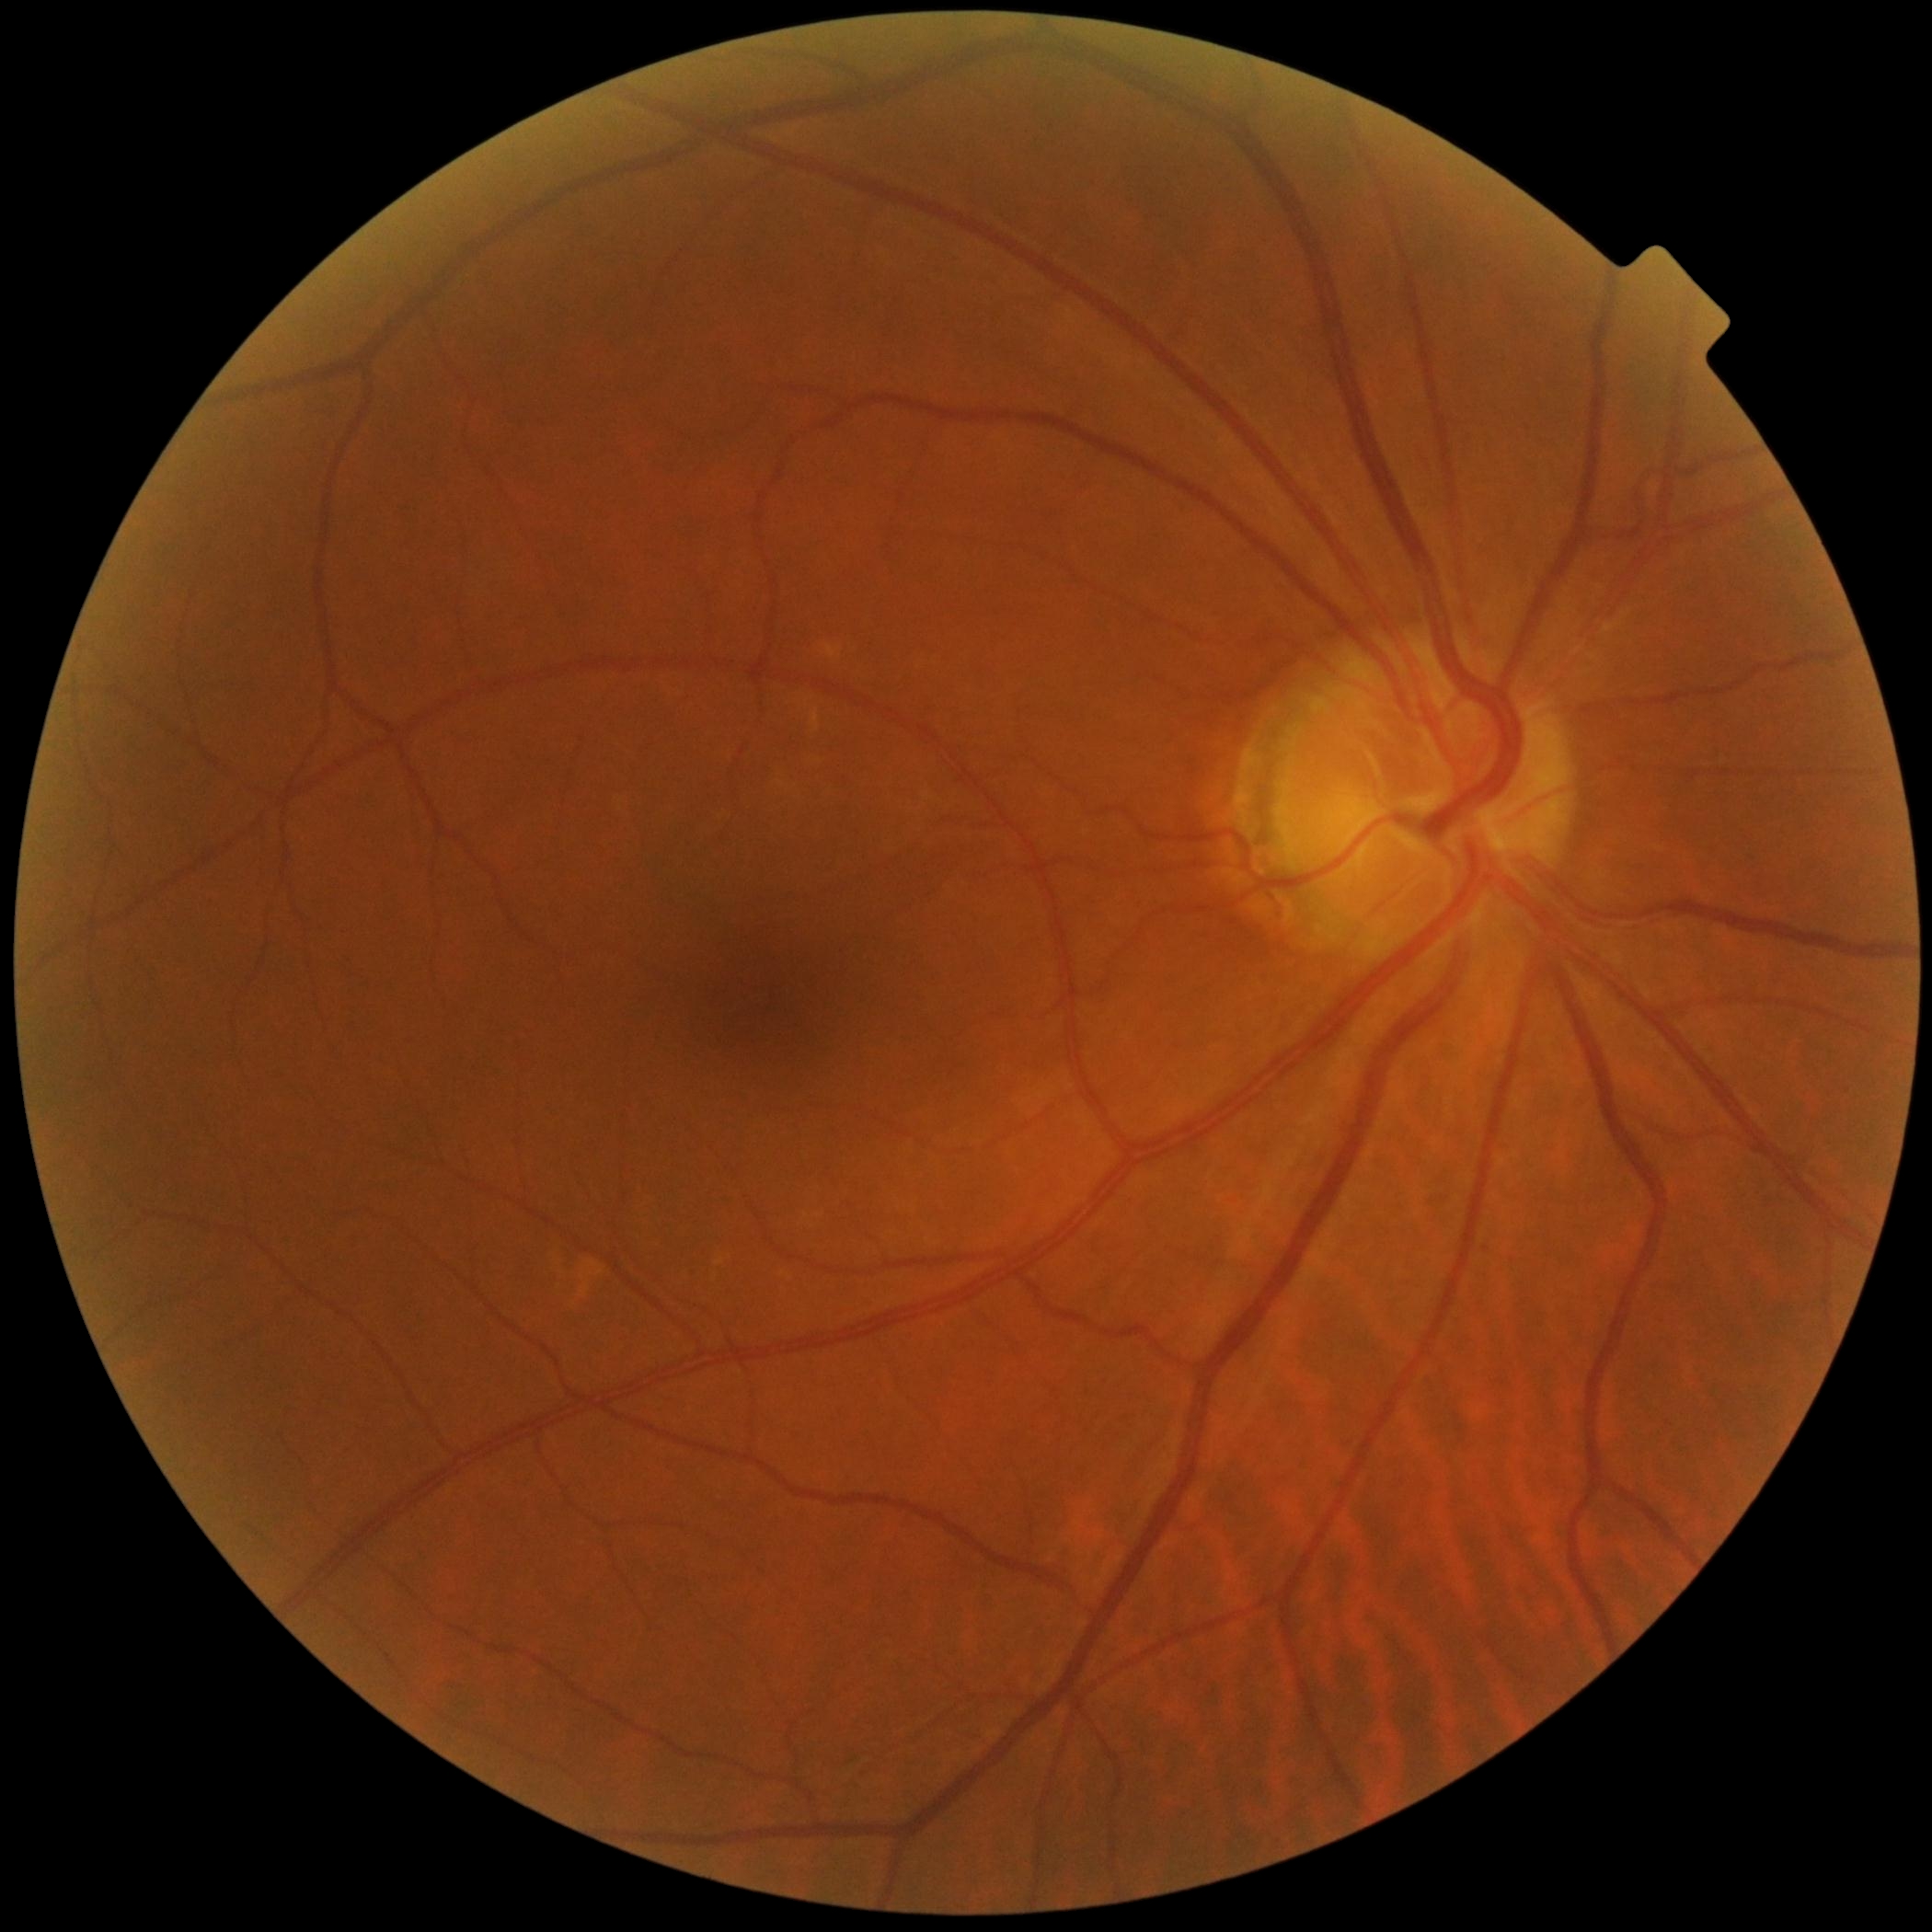

Diabetic retinopathy severity: no apparent retinopathy (grade 0).